Captured with the Phoenix ICON (100° field of view). Infant wide-field fundus photograph: 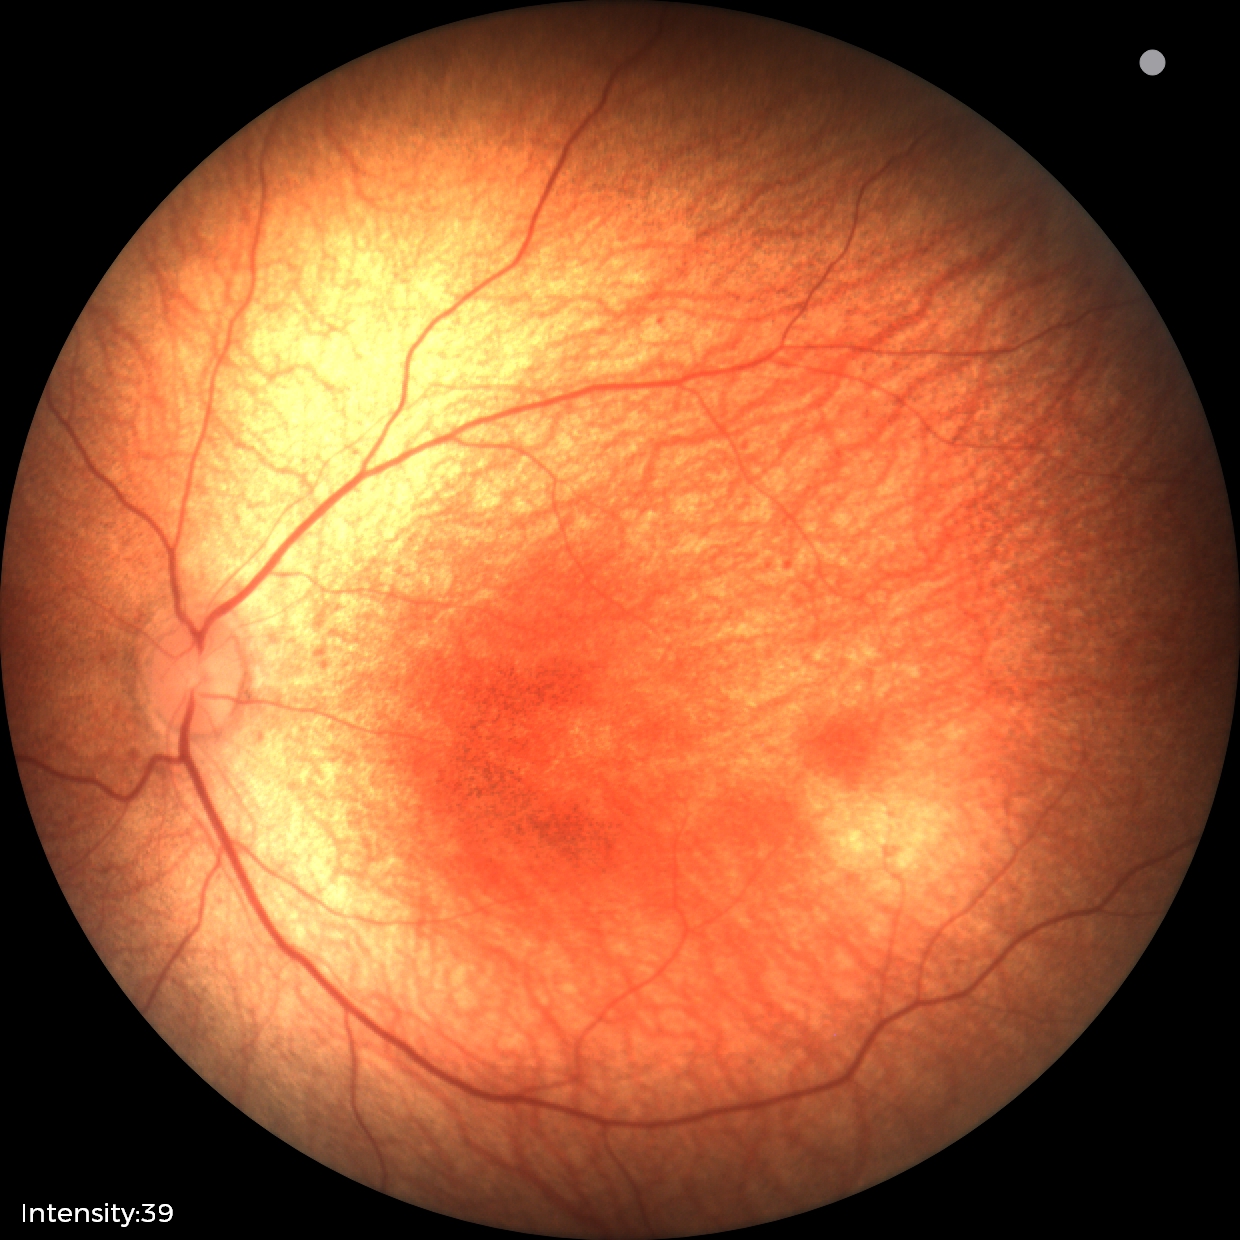
Examination with physiological retinal findings.